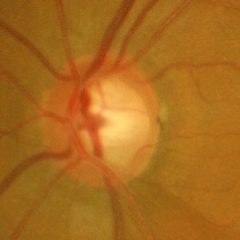 Glaucoma status = early glaucomatous changes.